Wide-field fundus photograph from neonatal ROP screening — 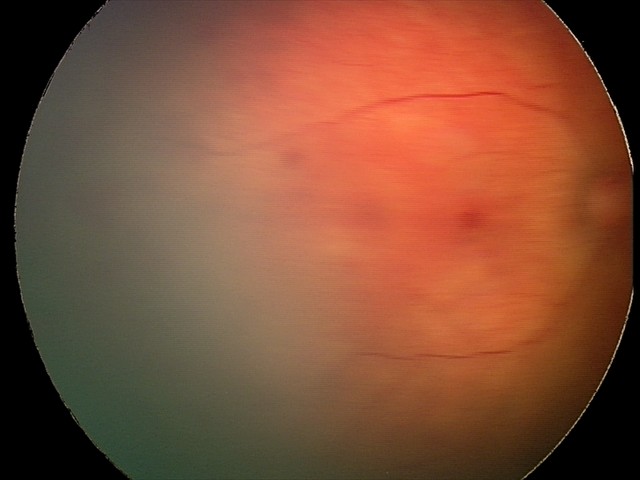 Screening examination consistent with retinal hemorrhages.